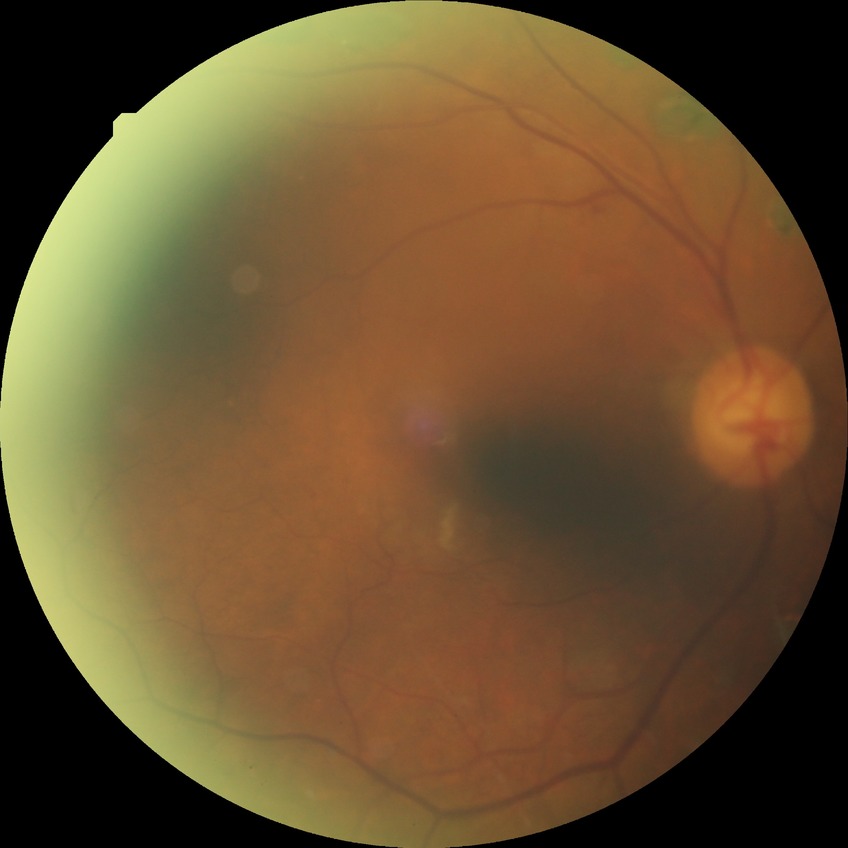 Modified Davis grading: proliferative diabetic retinopathy.